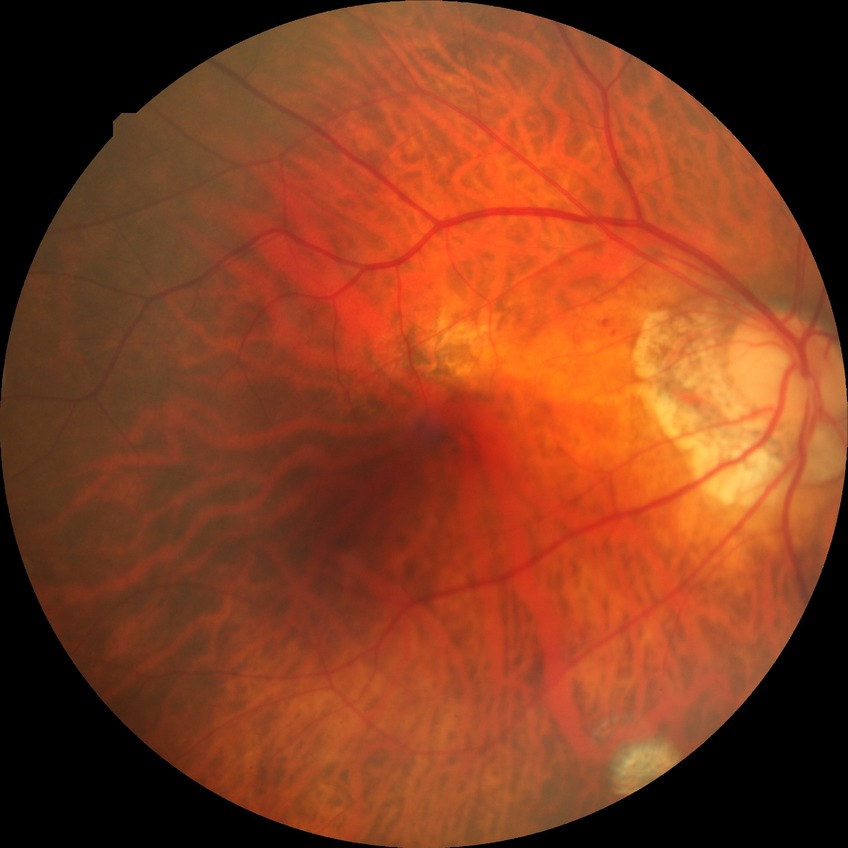 Annotations:
• DR grade: SDR